No pharmacologic dilation; 45-degree field of view:
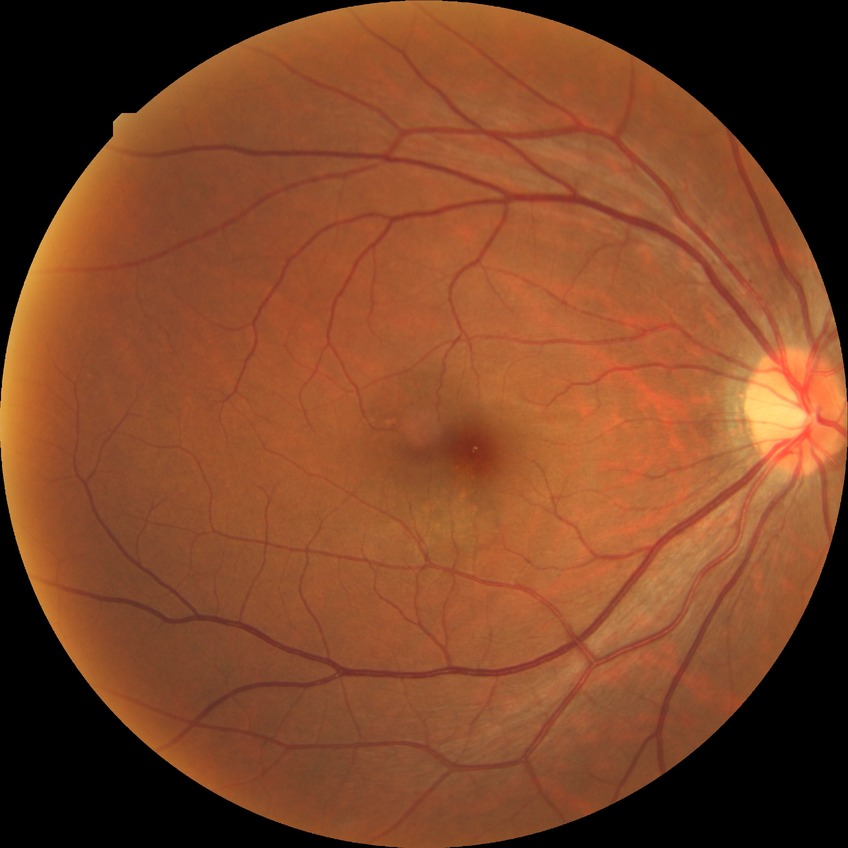
Annotations:
• DR: SDR
• DR class: non-proliferative diabetic retinopathy